240 by 240 pixels · captured without pupil dilation · optic disc region crop — 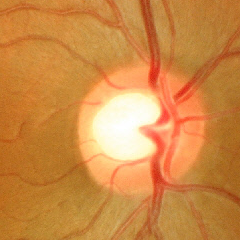

Demonstrates no signs of glaucoma.